Wide-field retinal mosaic image, image size 1924x1556
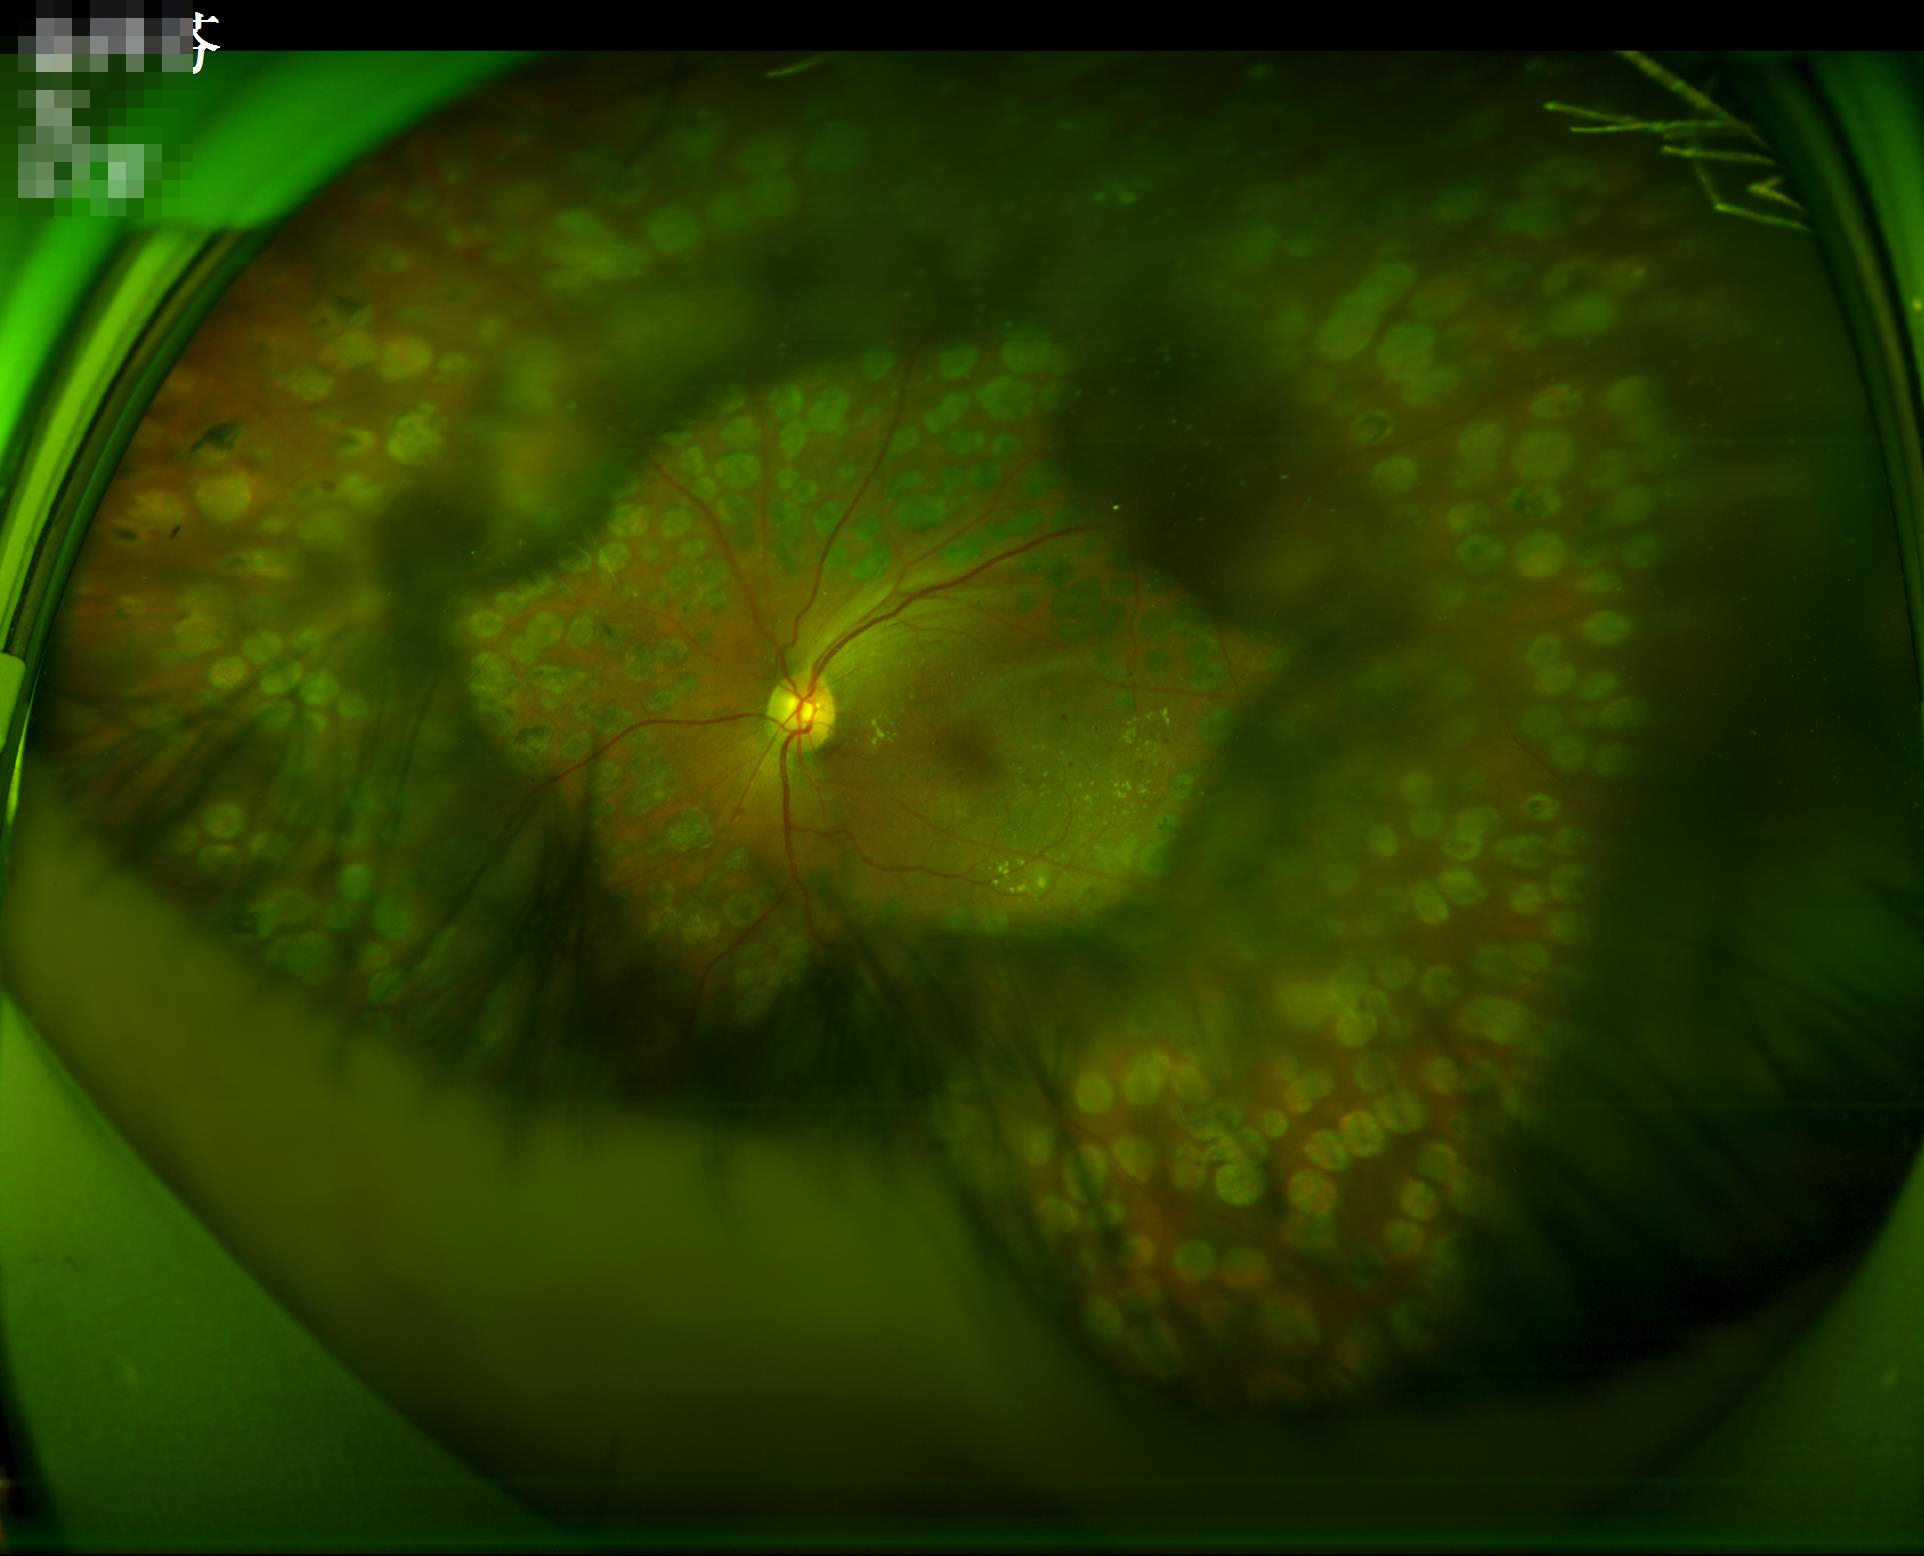
Good dynamic range. Out of focus; structures are indistinct. Overall image quality is poor. Illumination and color are suboptimal.